Retinal fundus photograph: 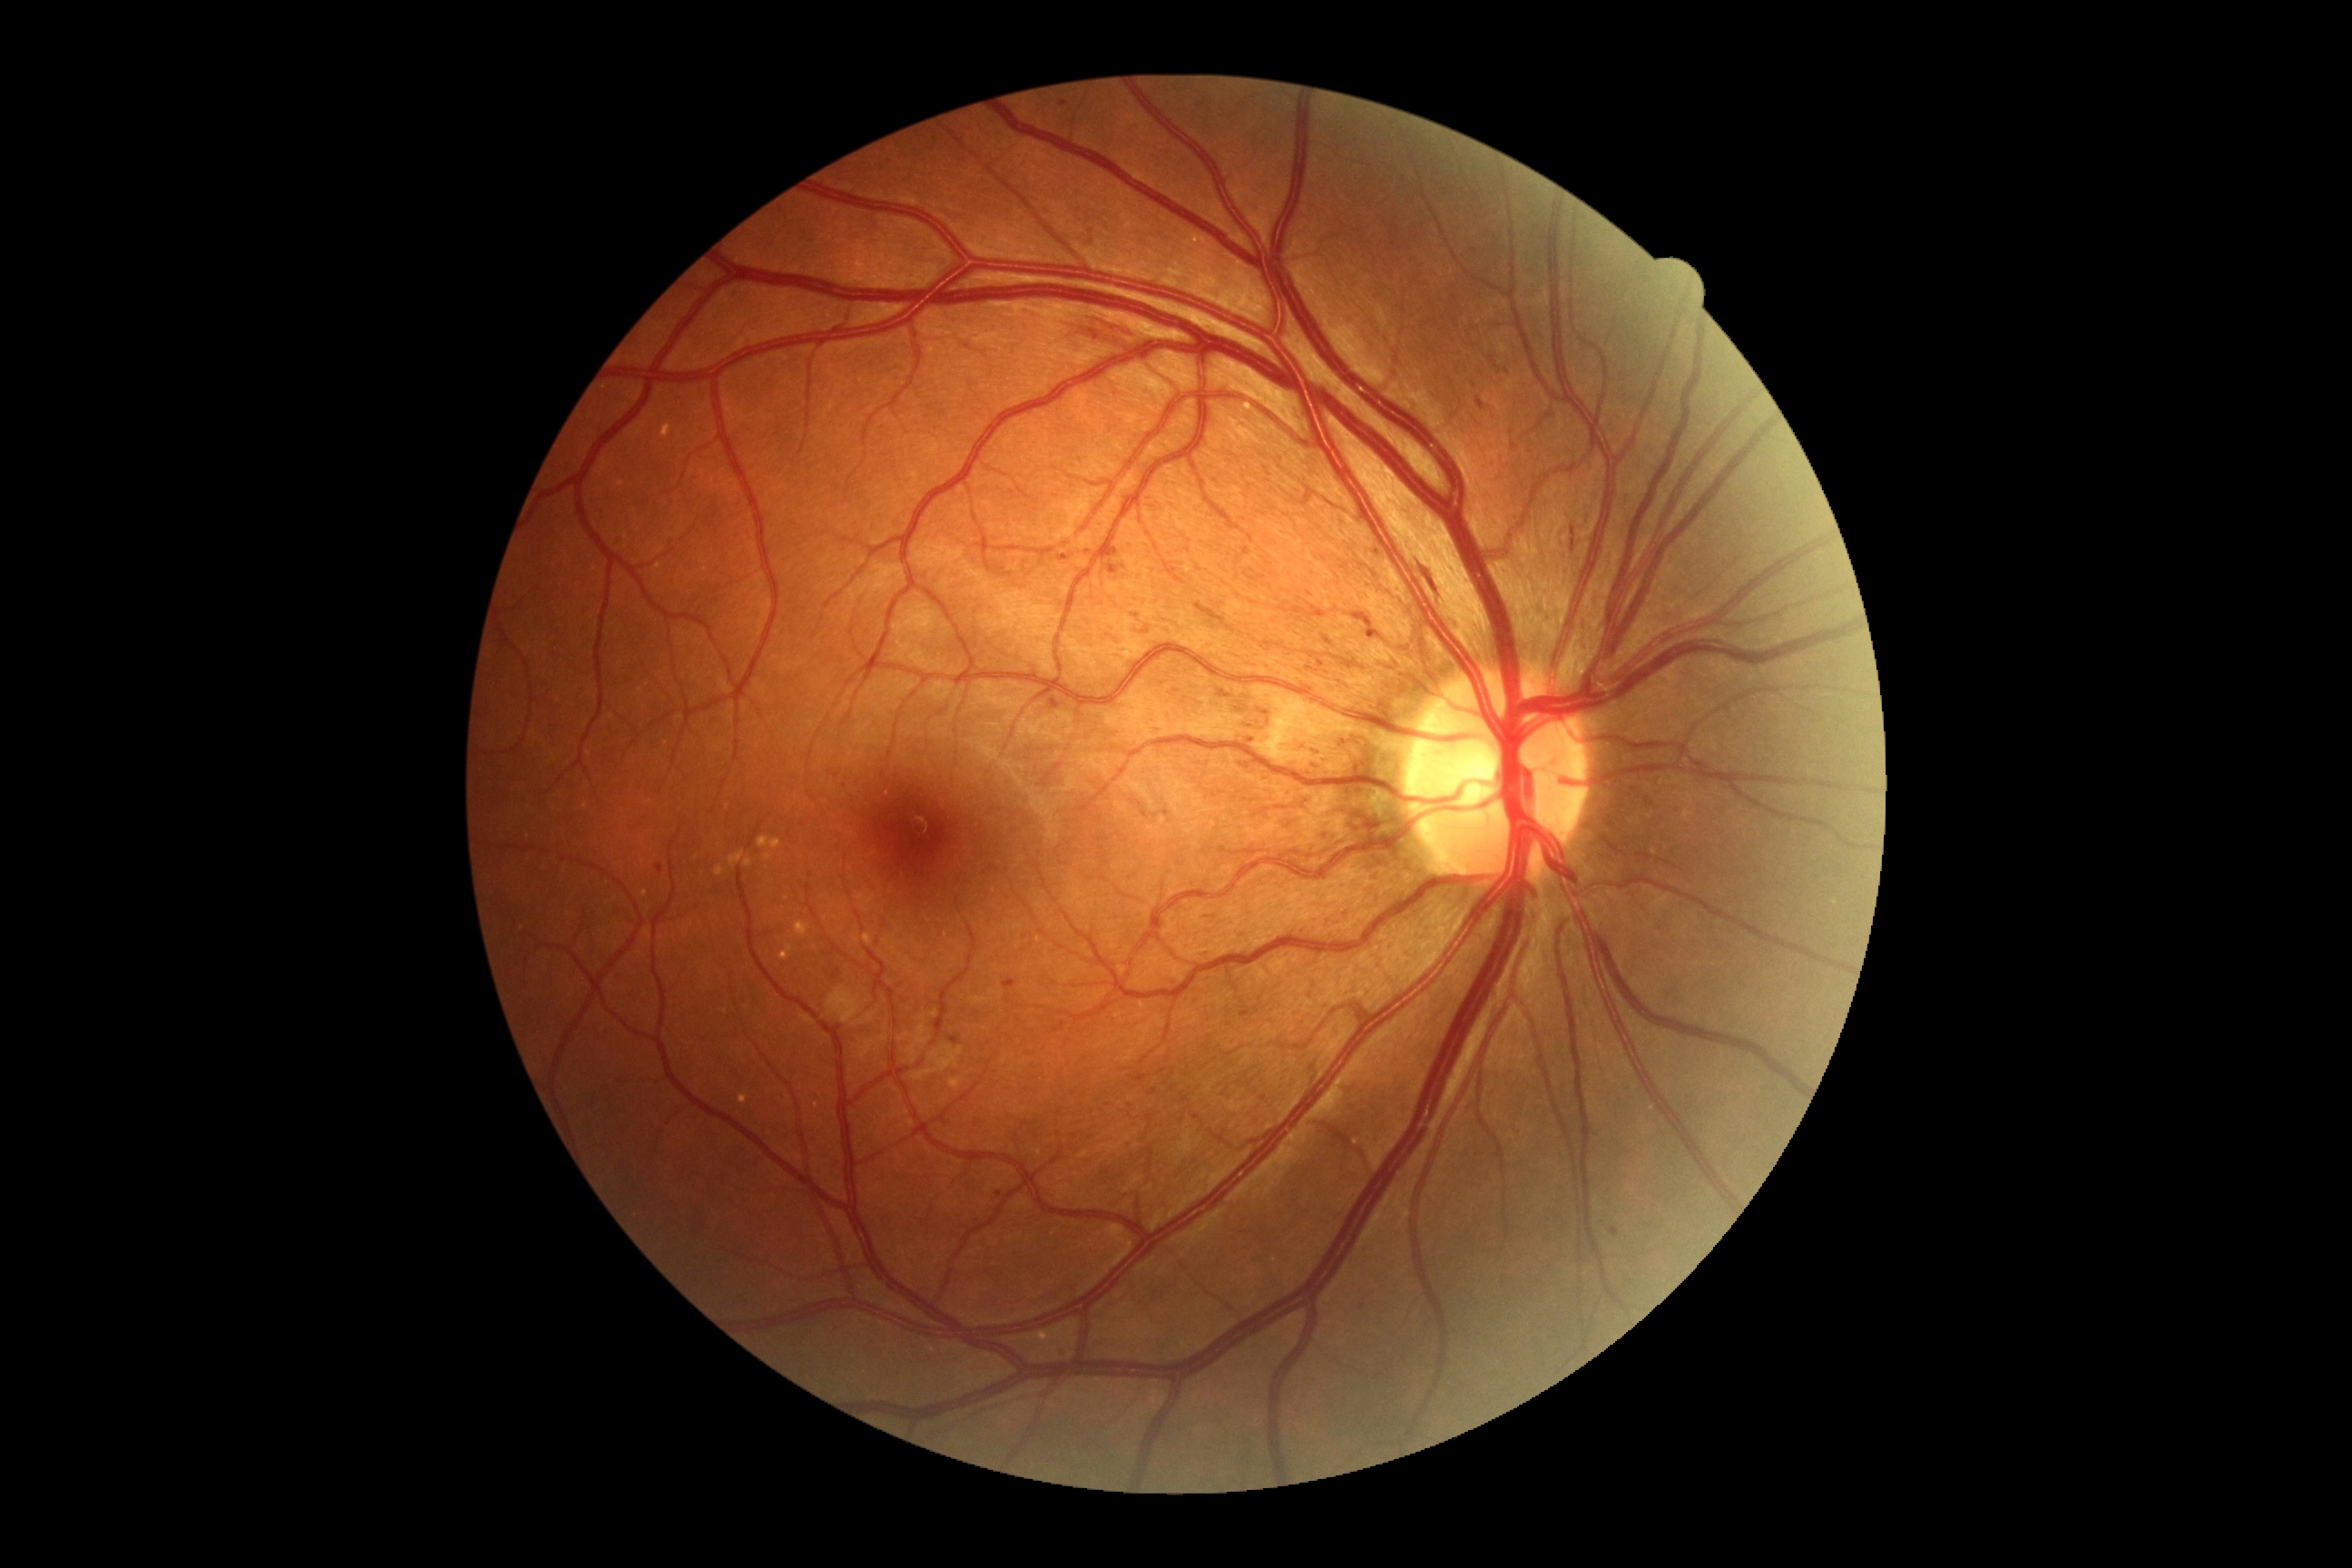 DR stage@grade 2 — more than just microaneurysms but less than severe NPDR.